Nonmydriatic fundus photograph; NIDEK AFC-230 fundus camera.
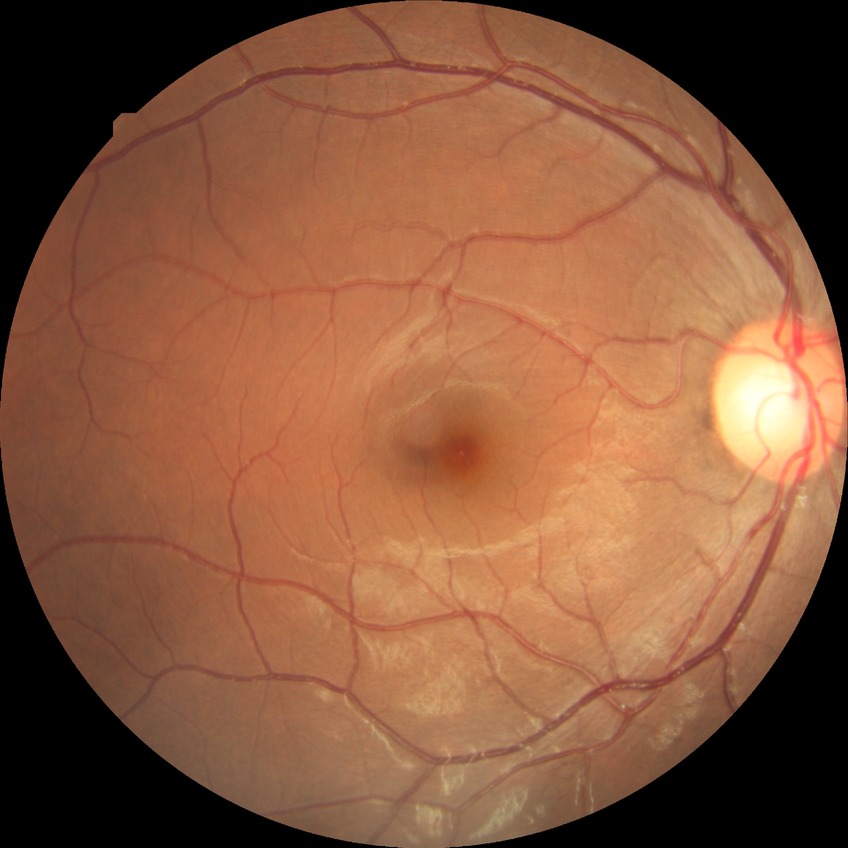 diabetic retinopathy (DR)=no diabetic retinopathy (NDR).